NIDEK AFC-230 fundus camera
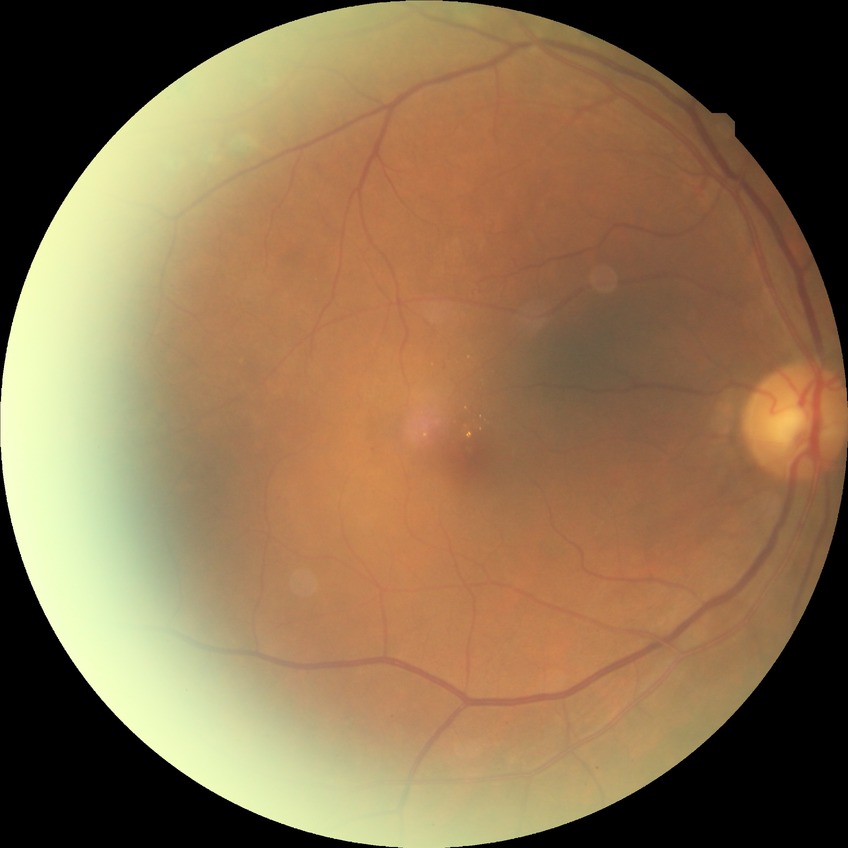 diabetic retinopathy grade: simple diabetic retinopathy.